CFP: 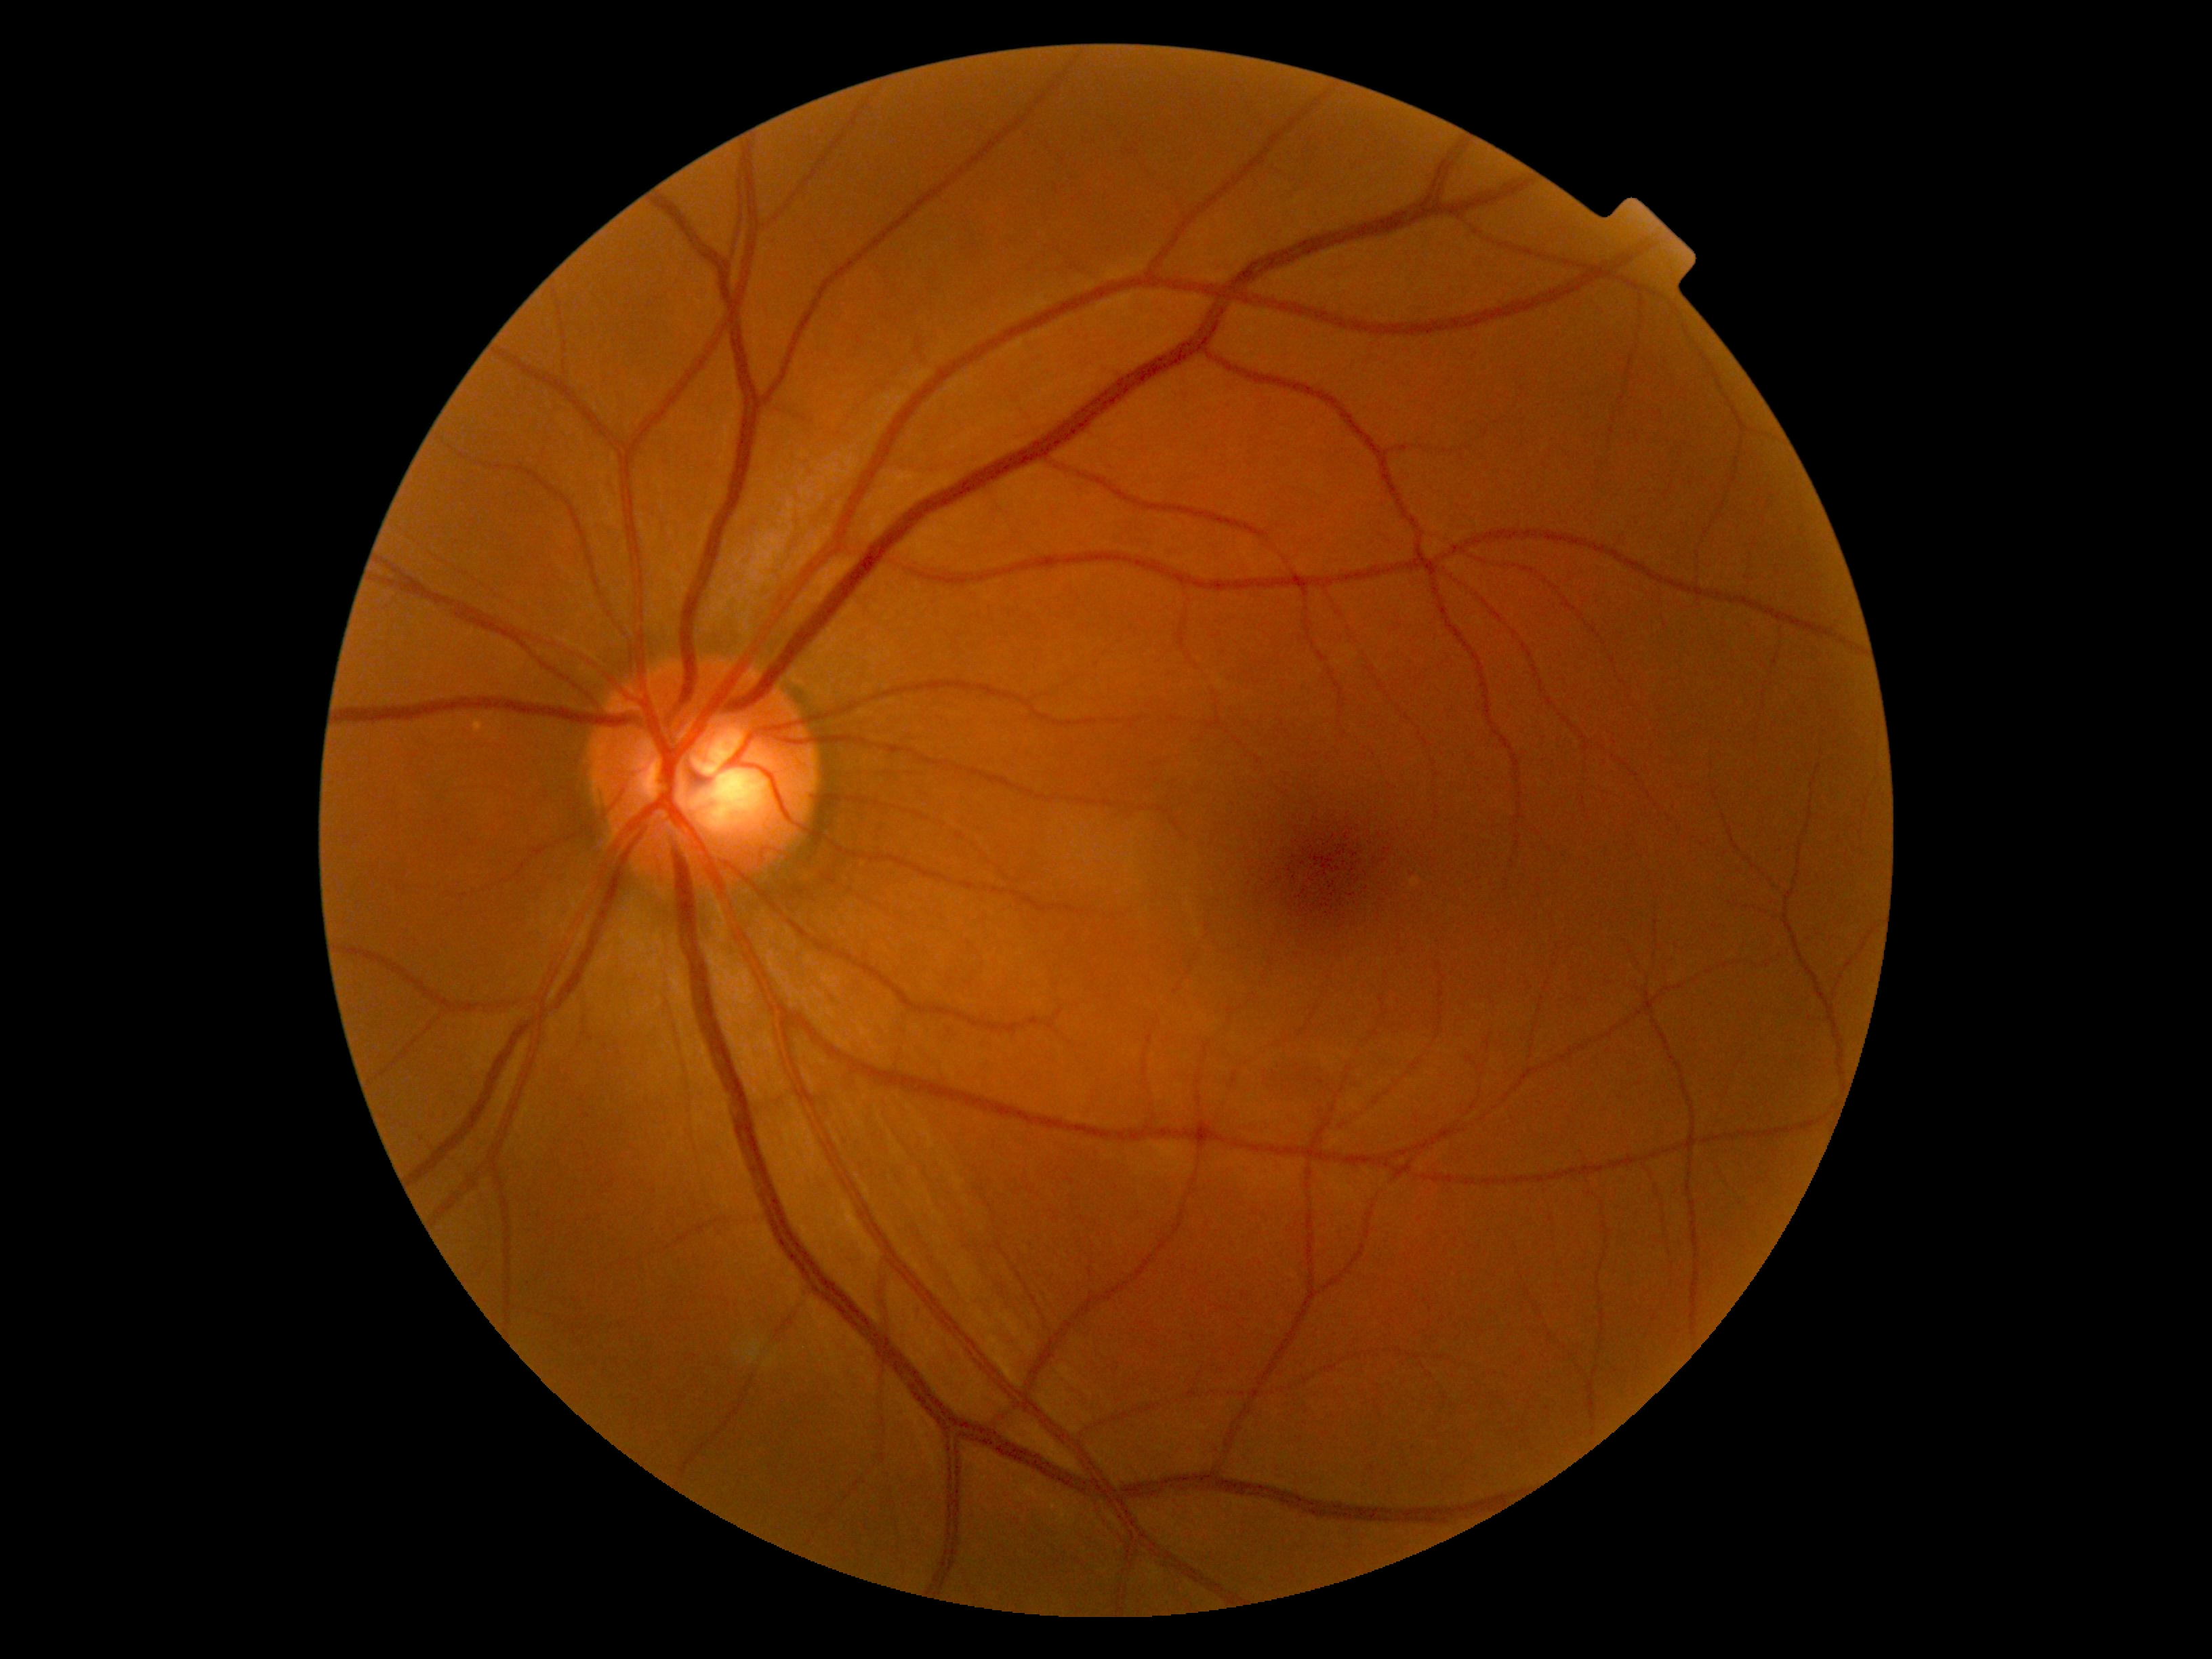 {
  "dr_grade": "0"
}